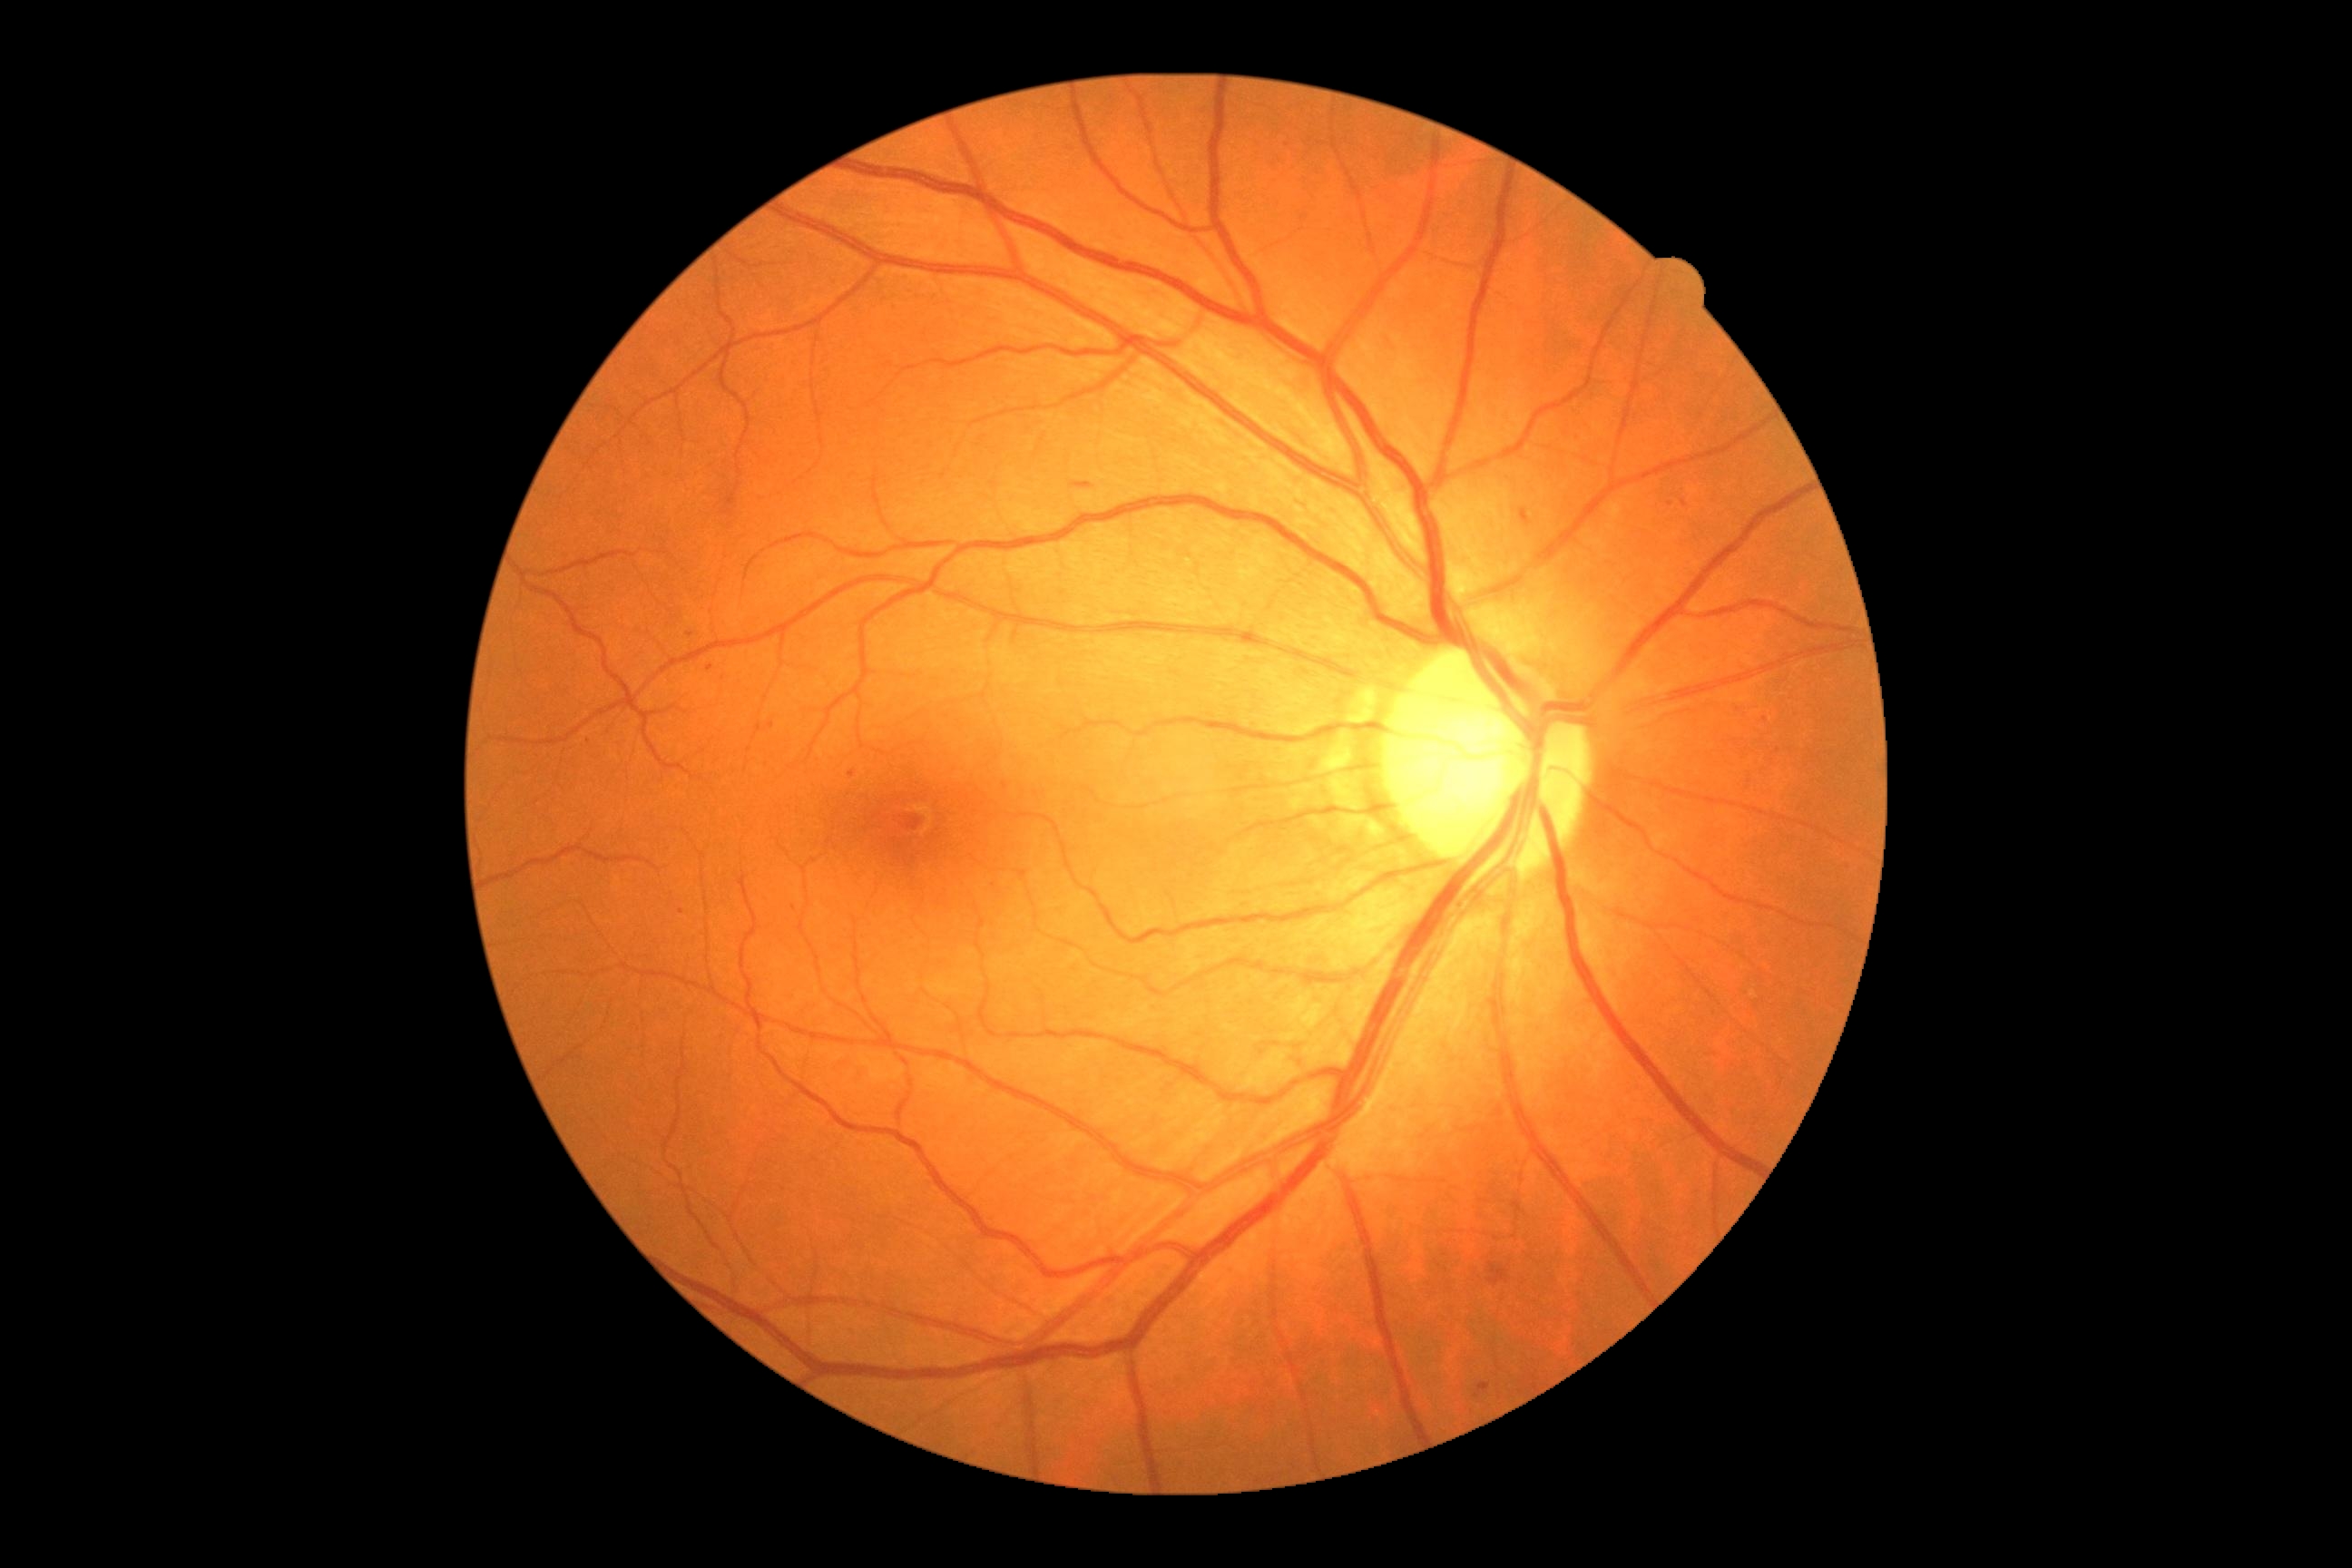 DR stage = 2/4.